NIDEK AFC-230:
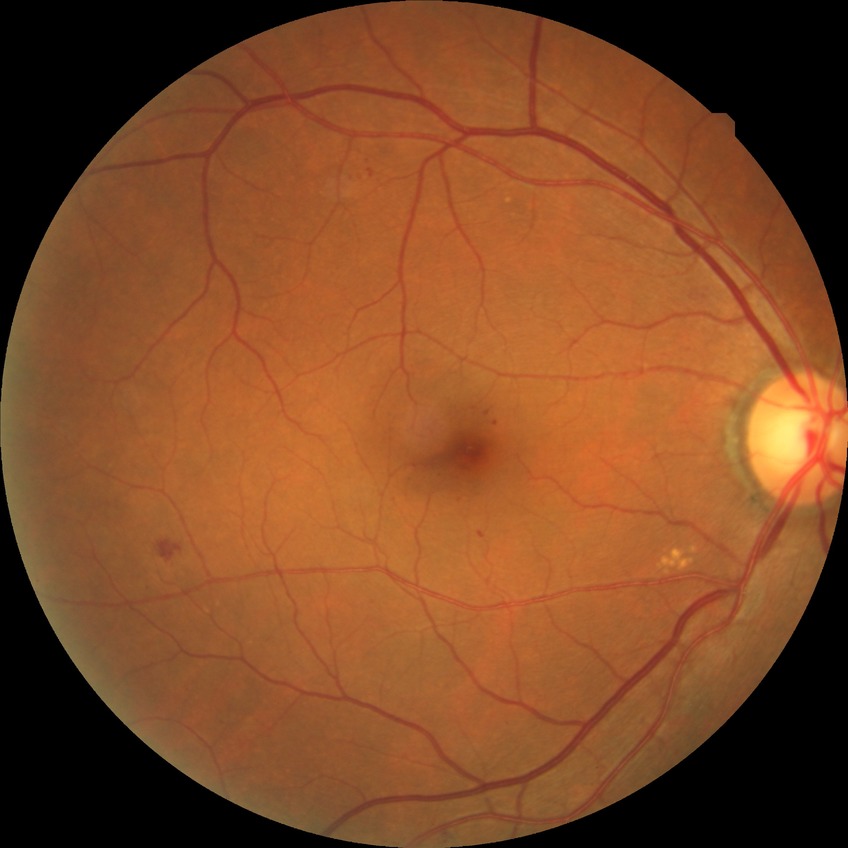 Modified Davis grading: simple diabetic retinopathy.